Kowa VX-10α — 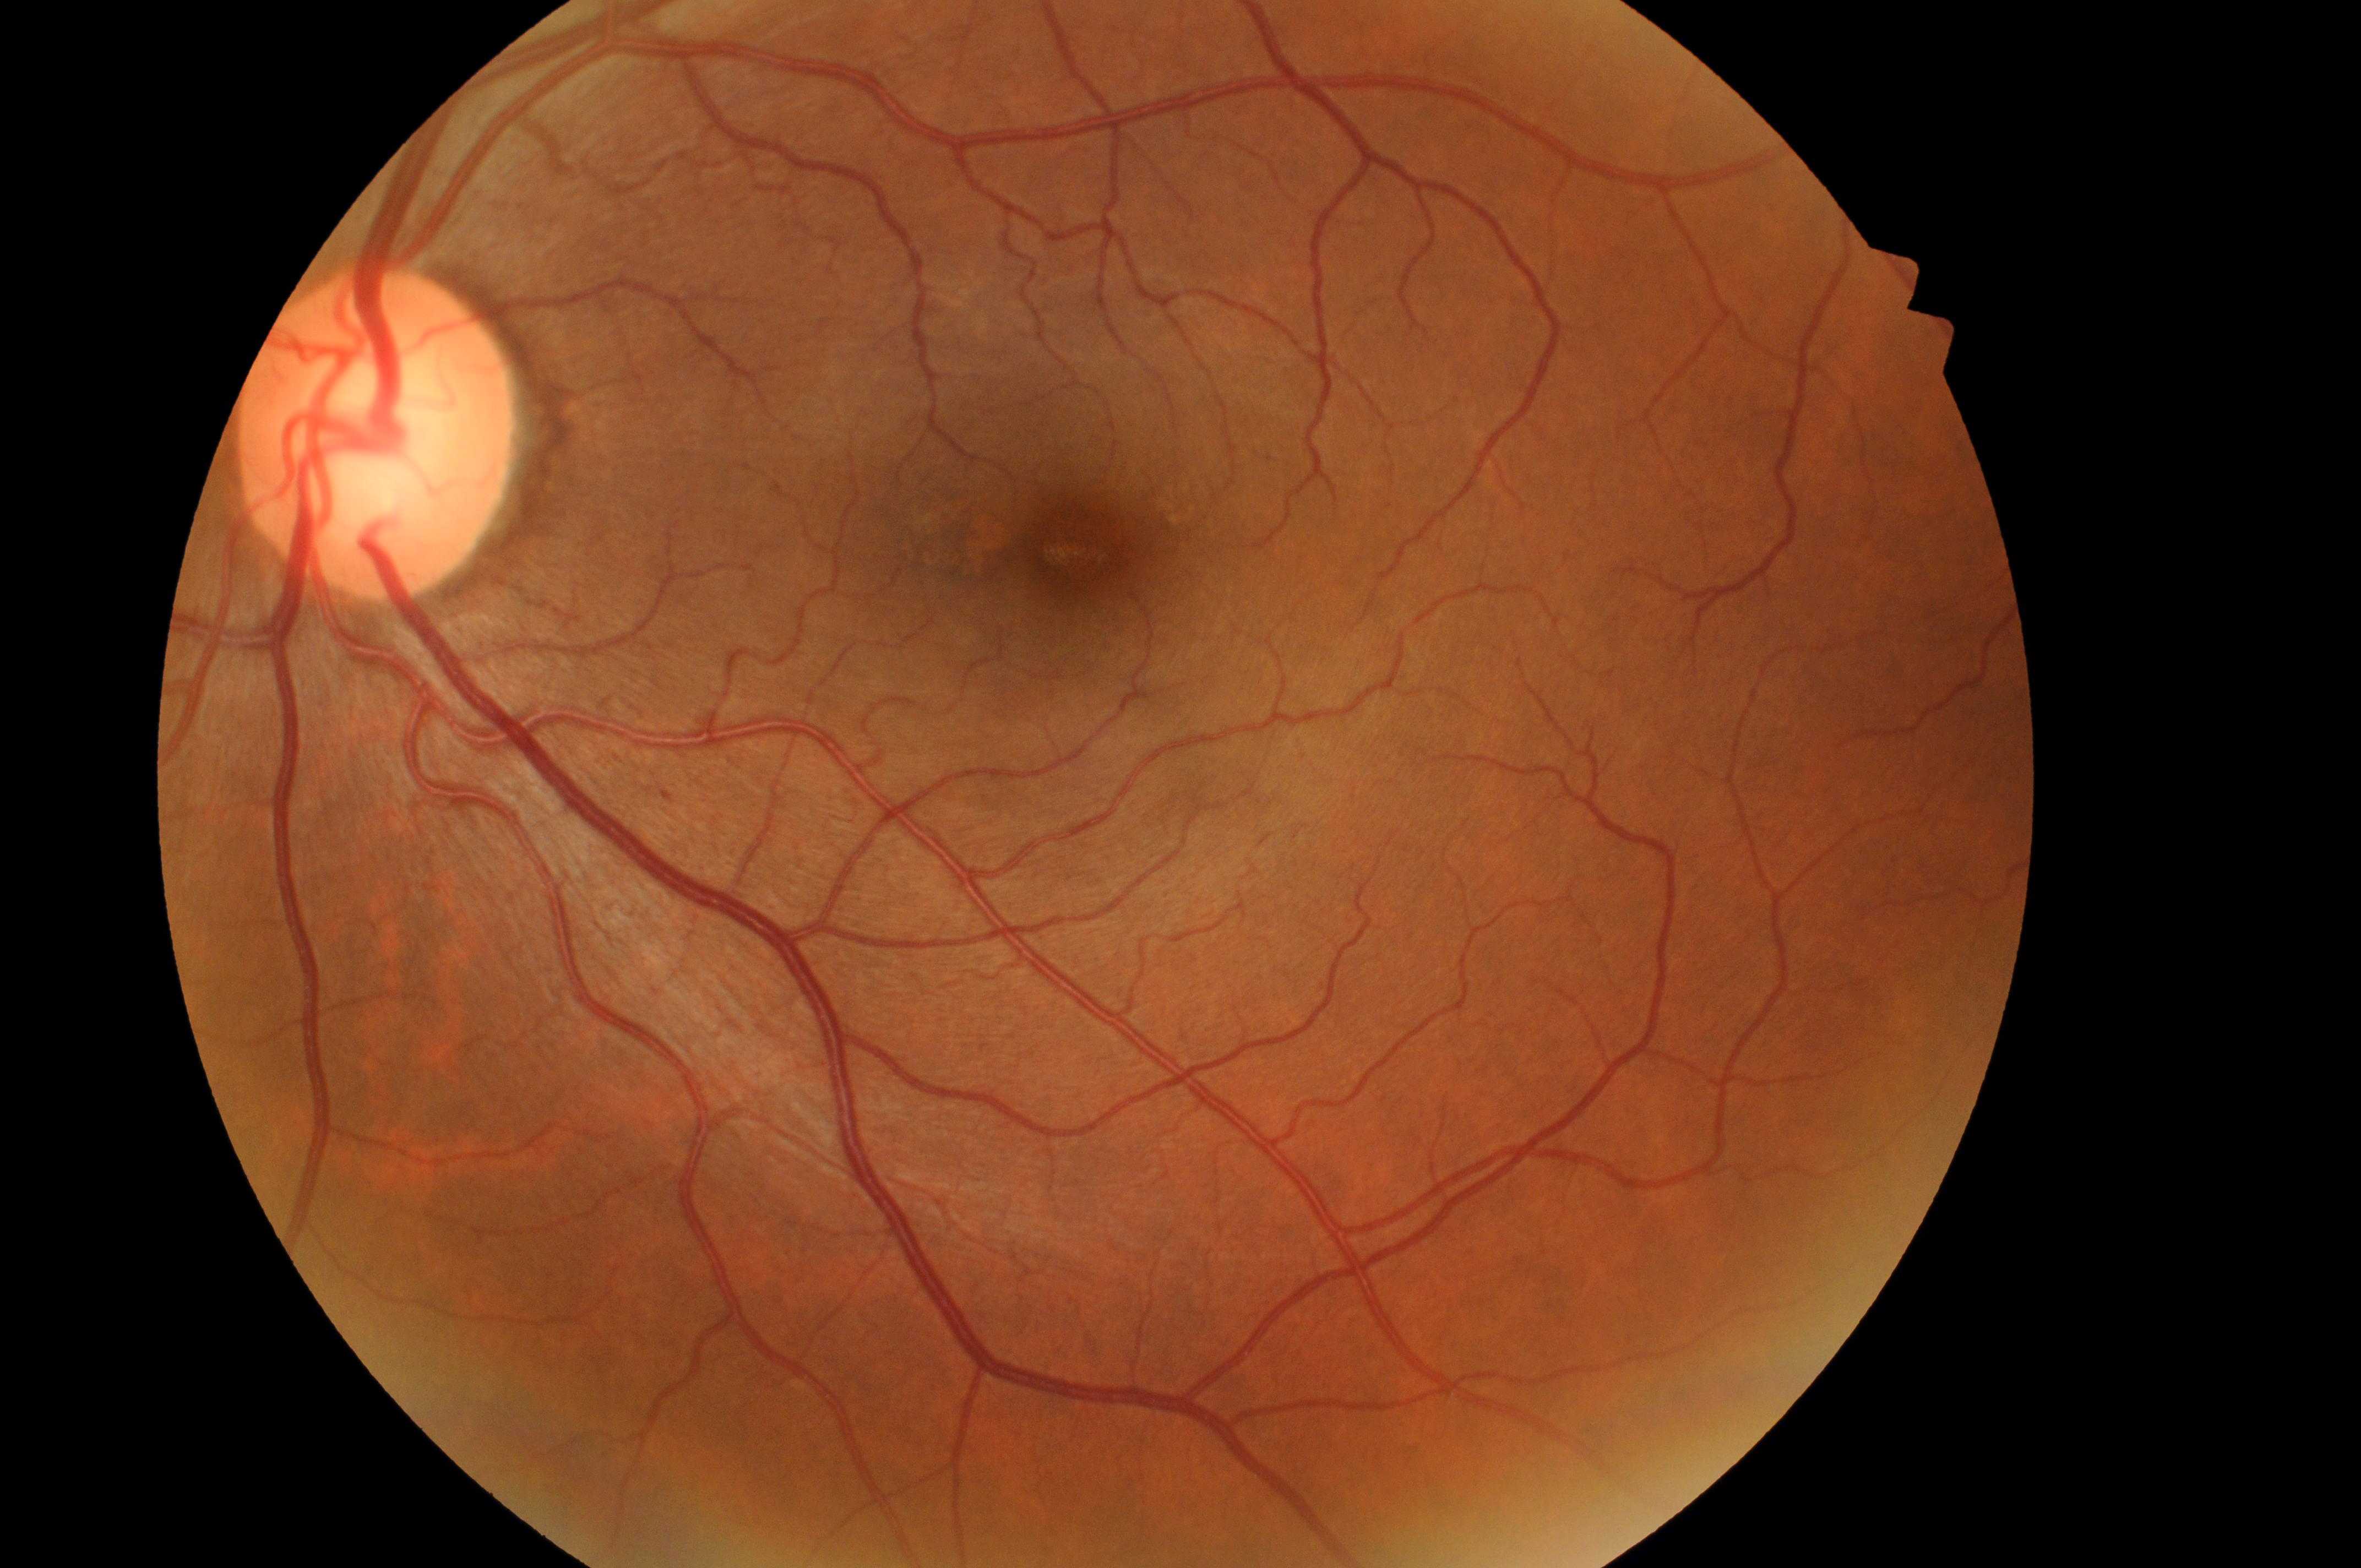 The fovea is at (1076, 546). DME risk: 0/2. DR stage is grade 1. Optic disk: (369, 447). Eye: left eye. Disease class: non-proliferative diabetic retinopathy.